848x848px.
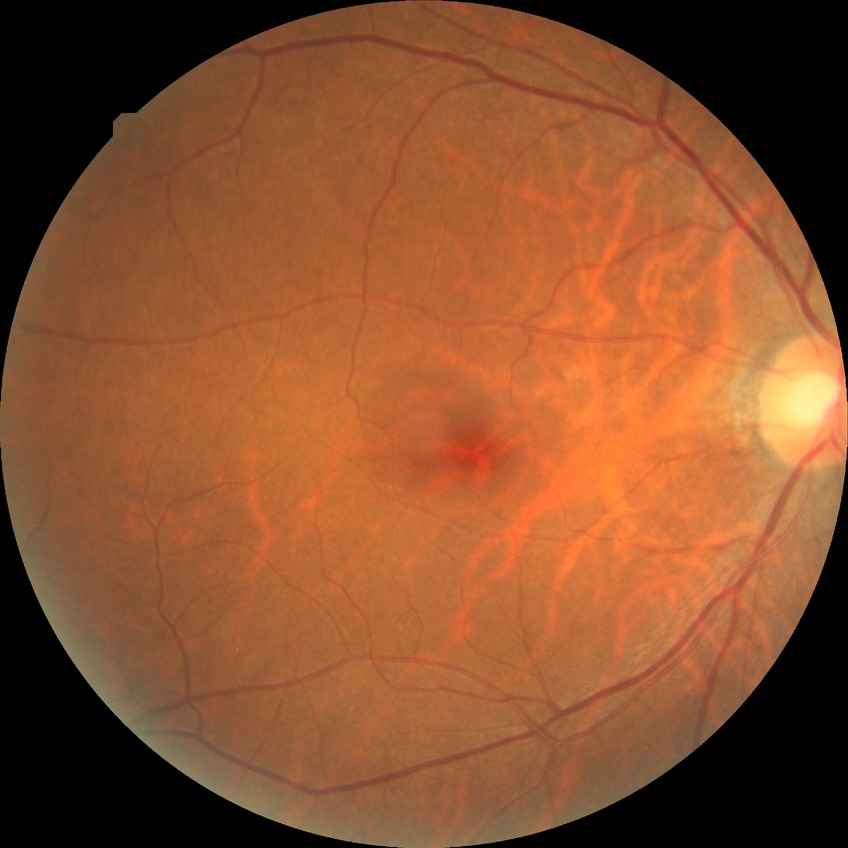 Diabetic retinopathy (DR): no diabetic retinopathy (NDR).